Wide-field fundus image from infant ROP screening — 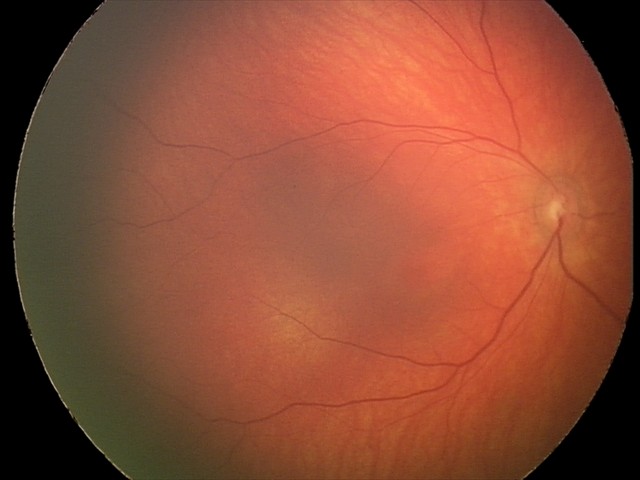
Finding = retinal hemorrhages.